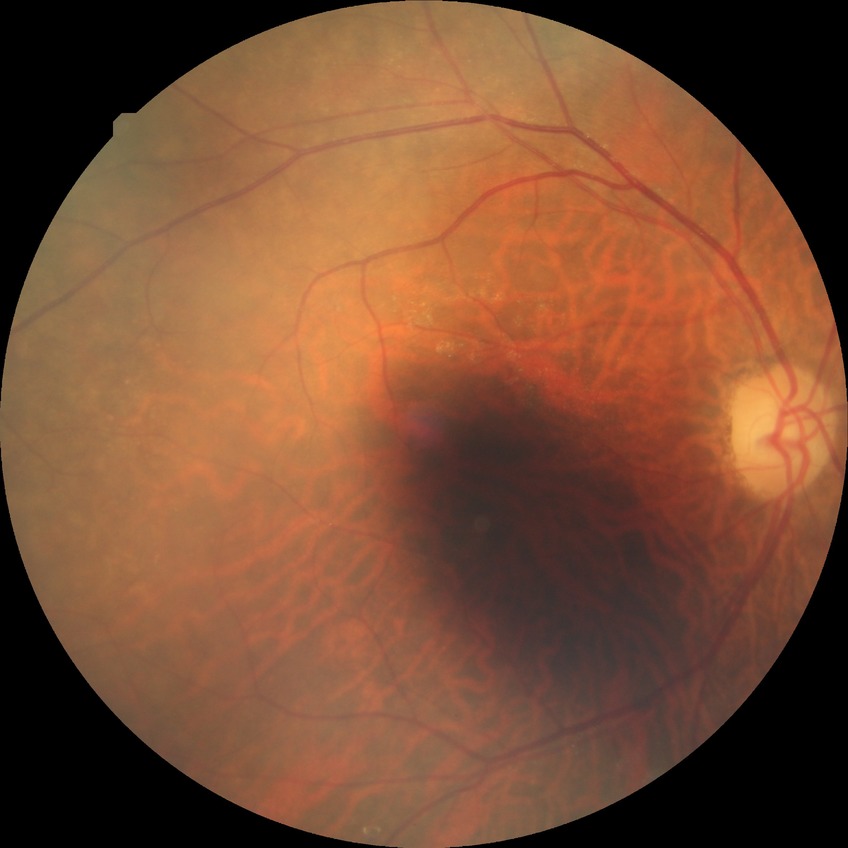
* modified Davis grade: NDR